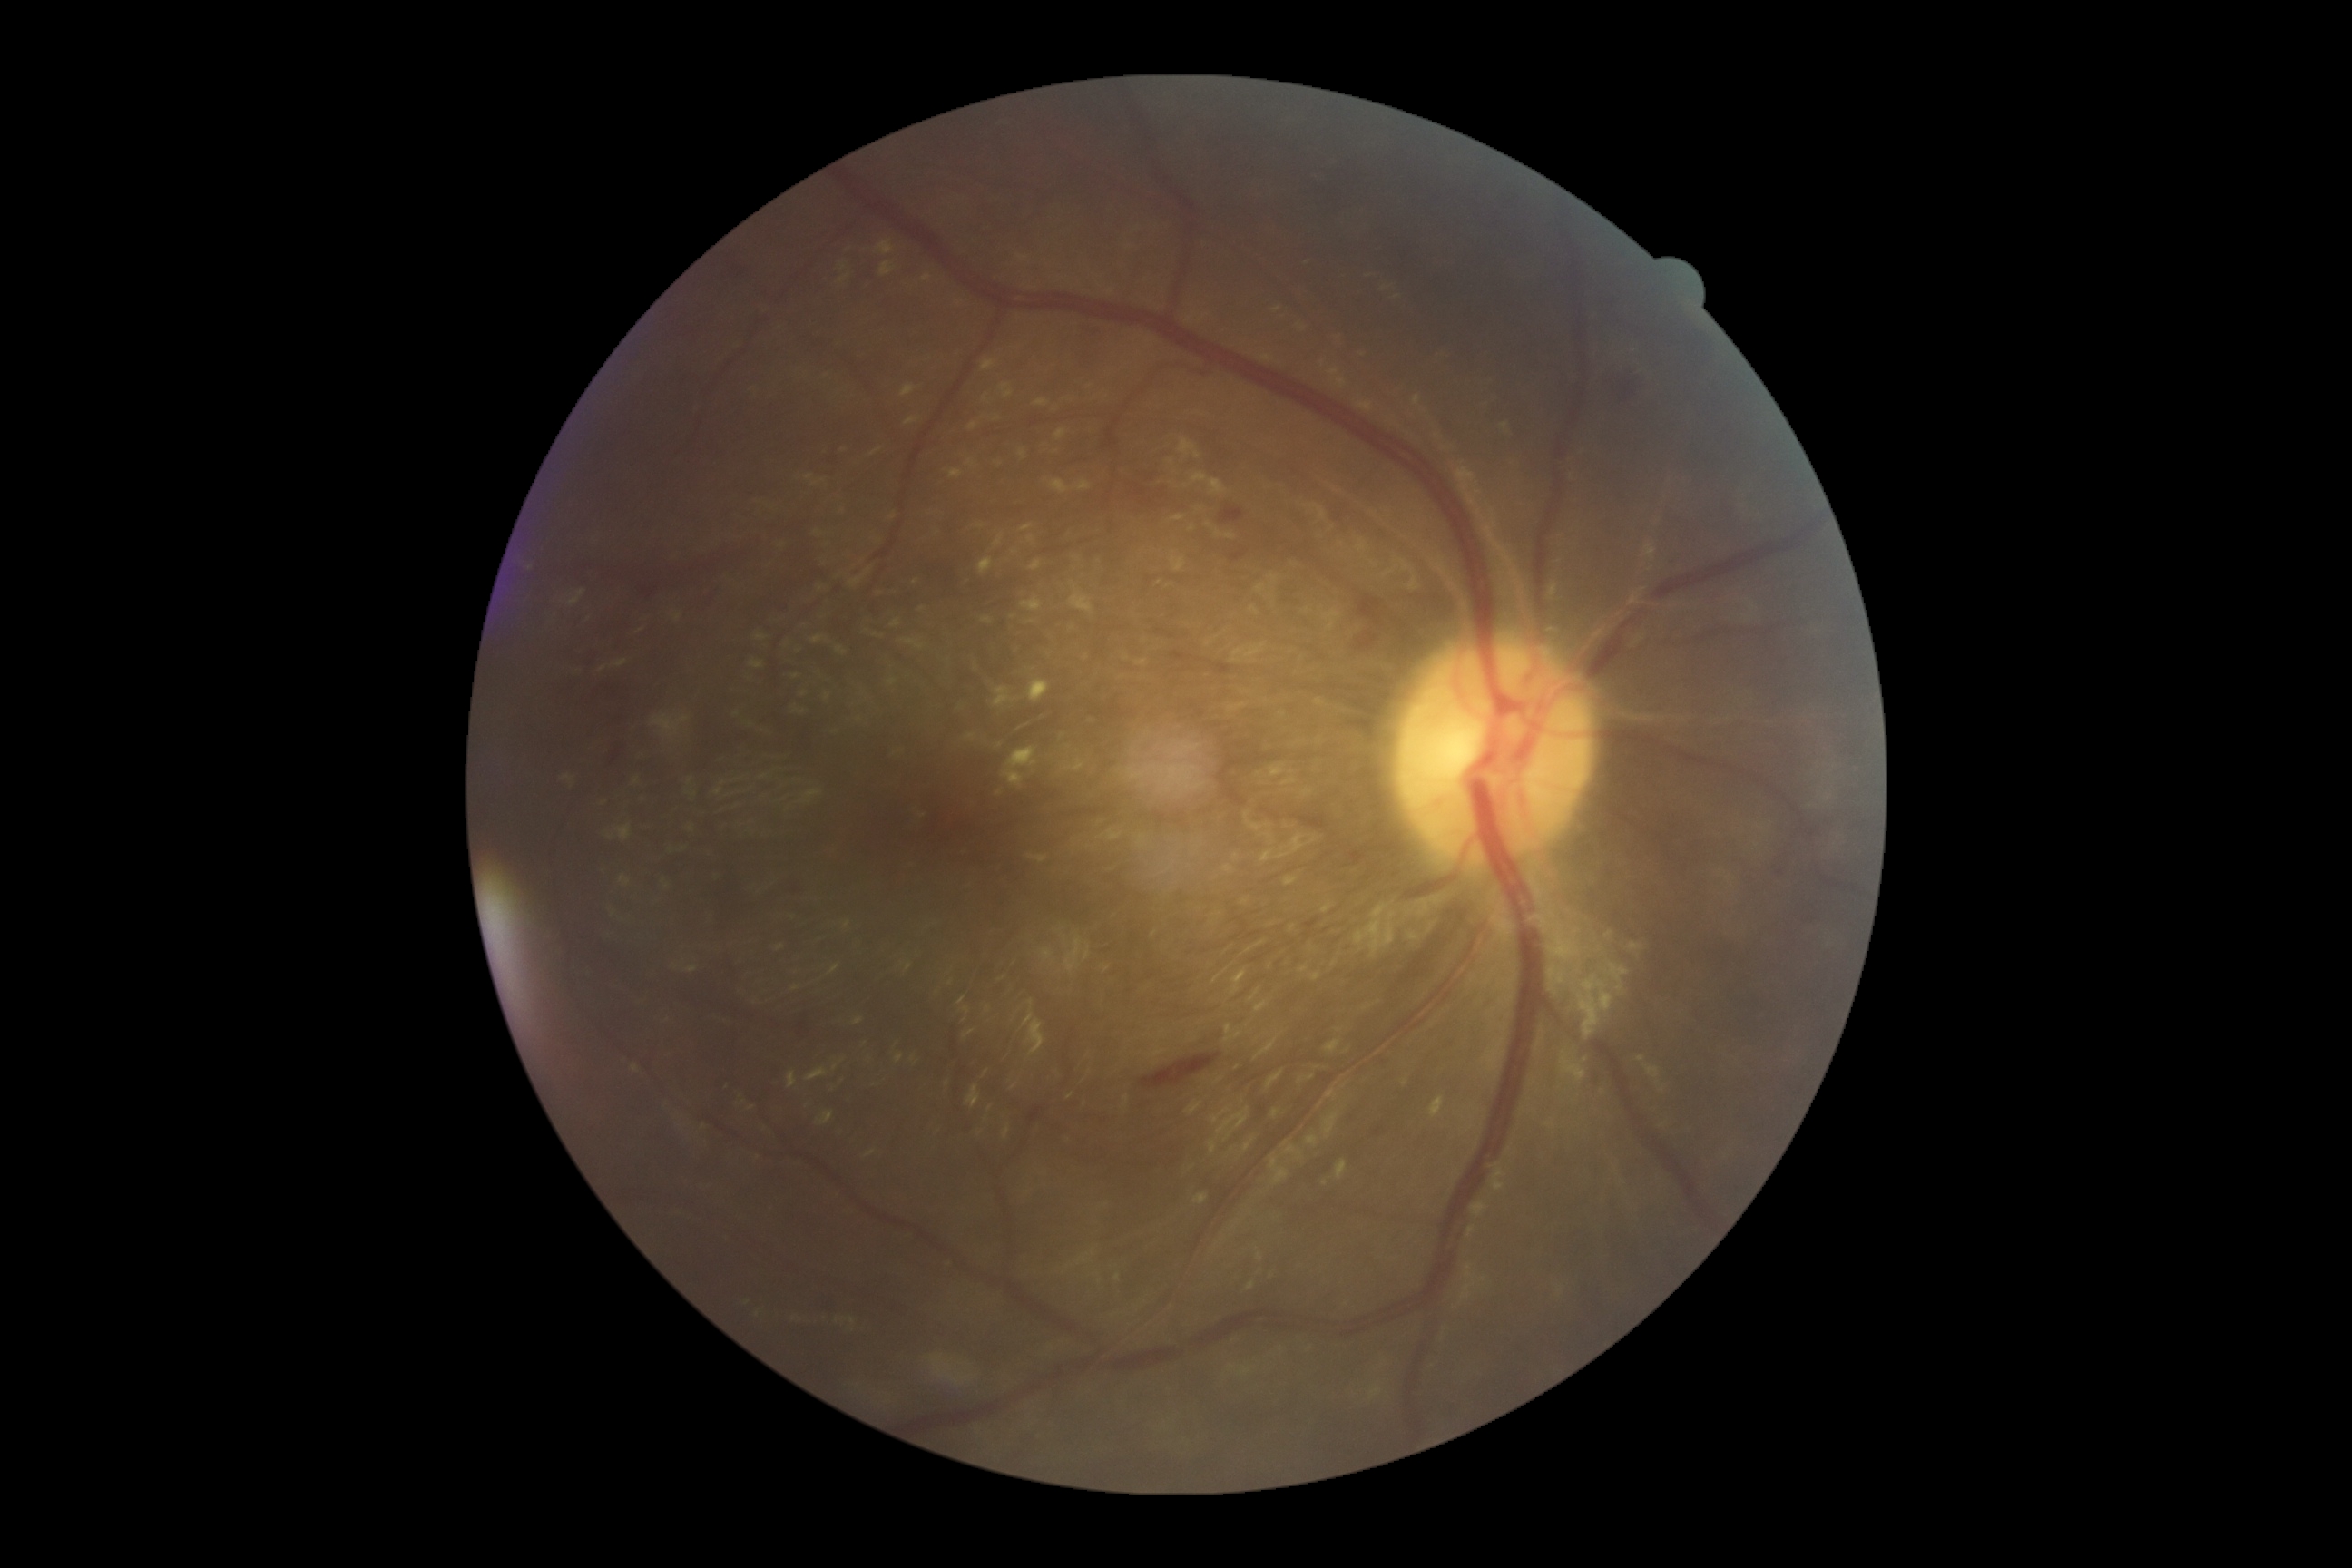

DR stage is moderate NPDR (grade 2)
Lesions identified (partial list):
MAs: absent
EXs (continued): left=923, top=275, right=932, bottom=282; left=950, top=469, right=963, bottom=478; left=1335, top=1161, right=1348, bottom=1181; left=994, top=687, right=1015, bottom=707; left=981, top=618, right=994, bottom=625; left=994, top=534, right=1004, bottom=549; left=1195, top=1193, right=1208, bottom=1204; left=876, top=240, right=896, bottom=257; left=1050, top=480, right=1070, bottom=495; left=901, top=386, right=916, bottom=398; left=1003, top=747, right=1039, bottom=787; left=1030, top=560, right=1041, bottom=573; left=1023, top=525, right=1034, bottom=533
Small EXs near x=844, y=267; x=1325, y=1183; x=1014, y=618
SEs: absent
HEs (continued): left=1171, top=651, right=1191, bottom=662; left=710, top=260, right=750, bottom=295; left=1358, top=596, right=1380, bottom=620; left=1231, top=551, right=1246, bottom=562; left=1612, top=369, right=1649, bottom=402; left=818, top=1298, right=841, bottom=1318; left=1117, top=471, right=1210, bottom=524; left=1141, top=1054, right=1222, bottom=1090; left=1774, top=850, right=1796, bottom=883; left=1358, top=632, right=1377, bottom=651; left=1220, top=507, right=1244, bottom=524; left=520, top=567, right=725, bottom=805; left=1077, top=324, right=1106, bottom=346